Macula at the center of the field.
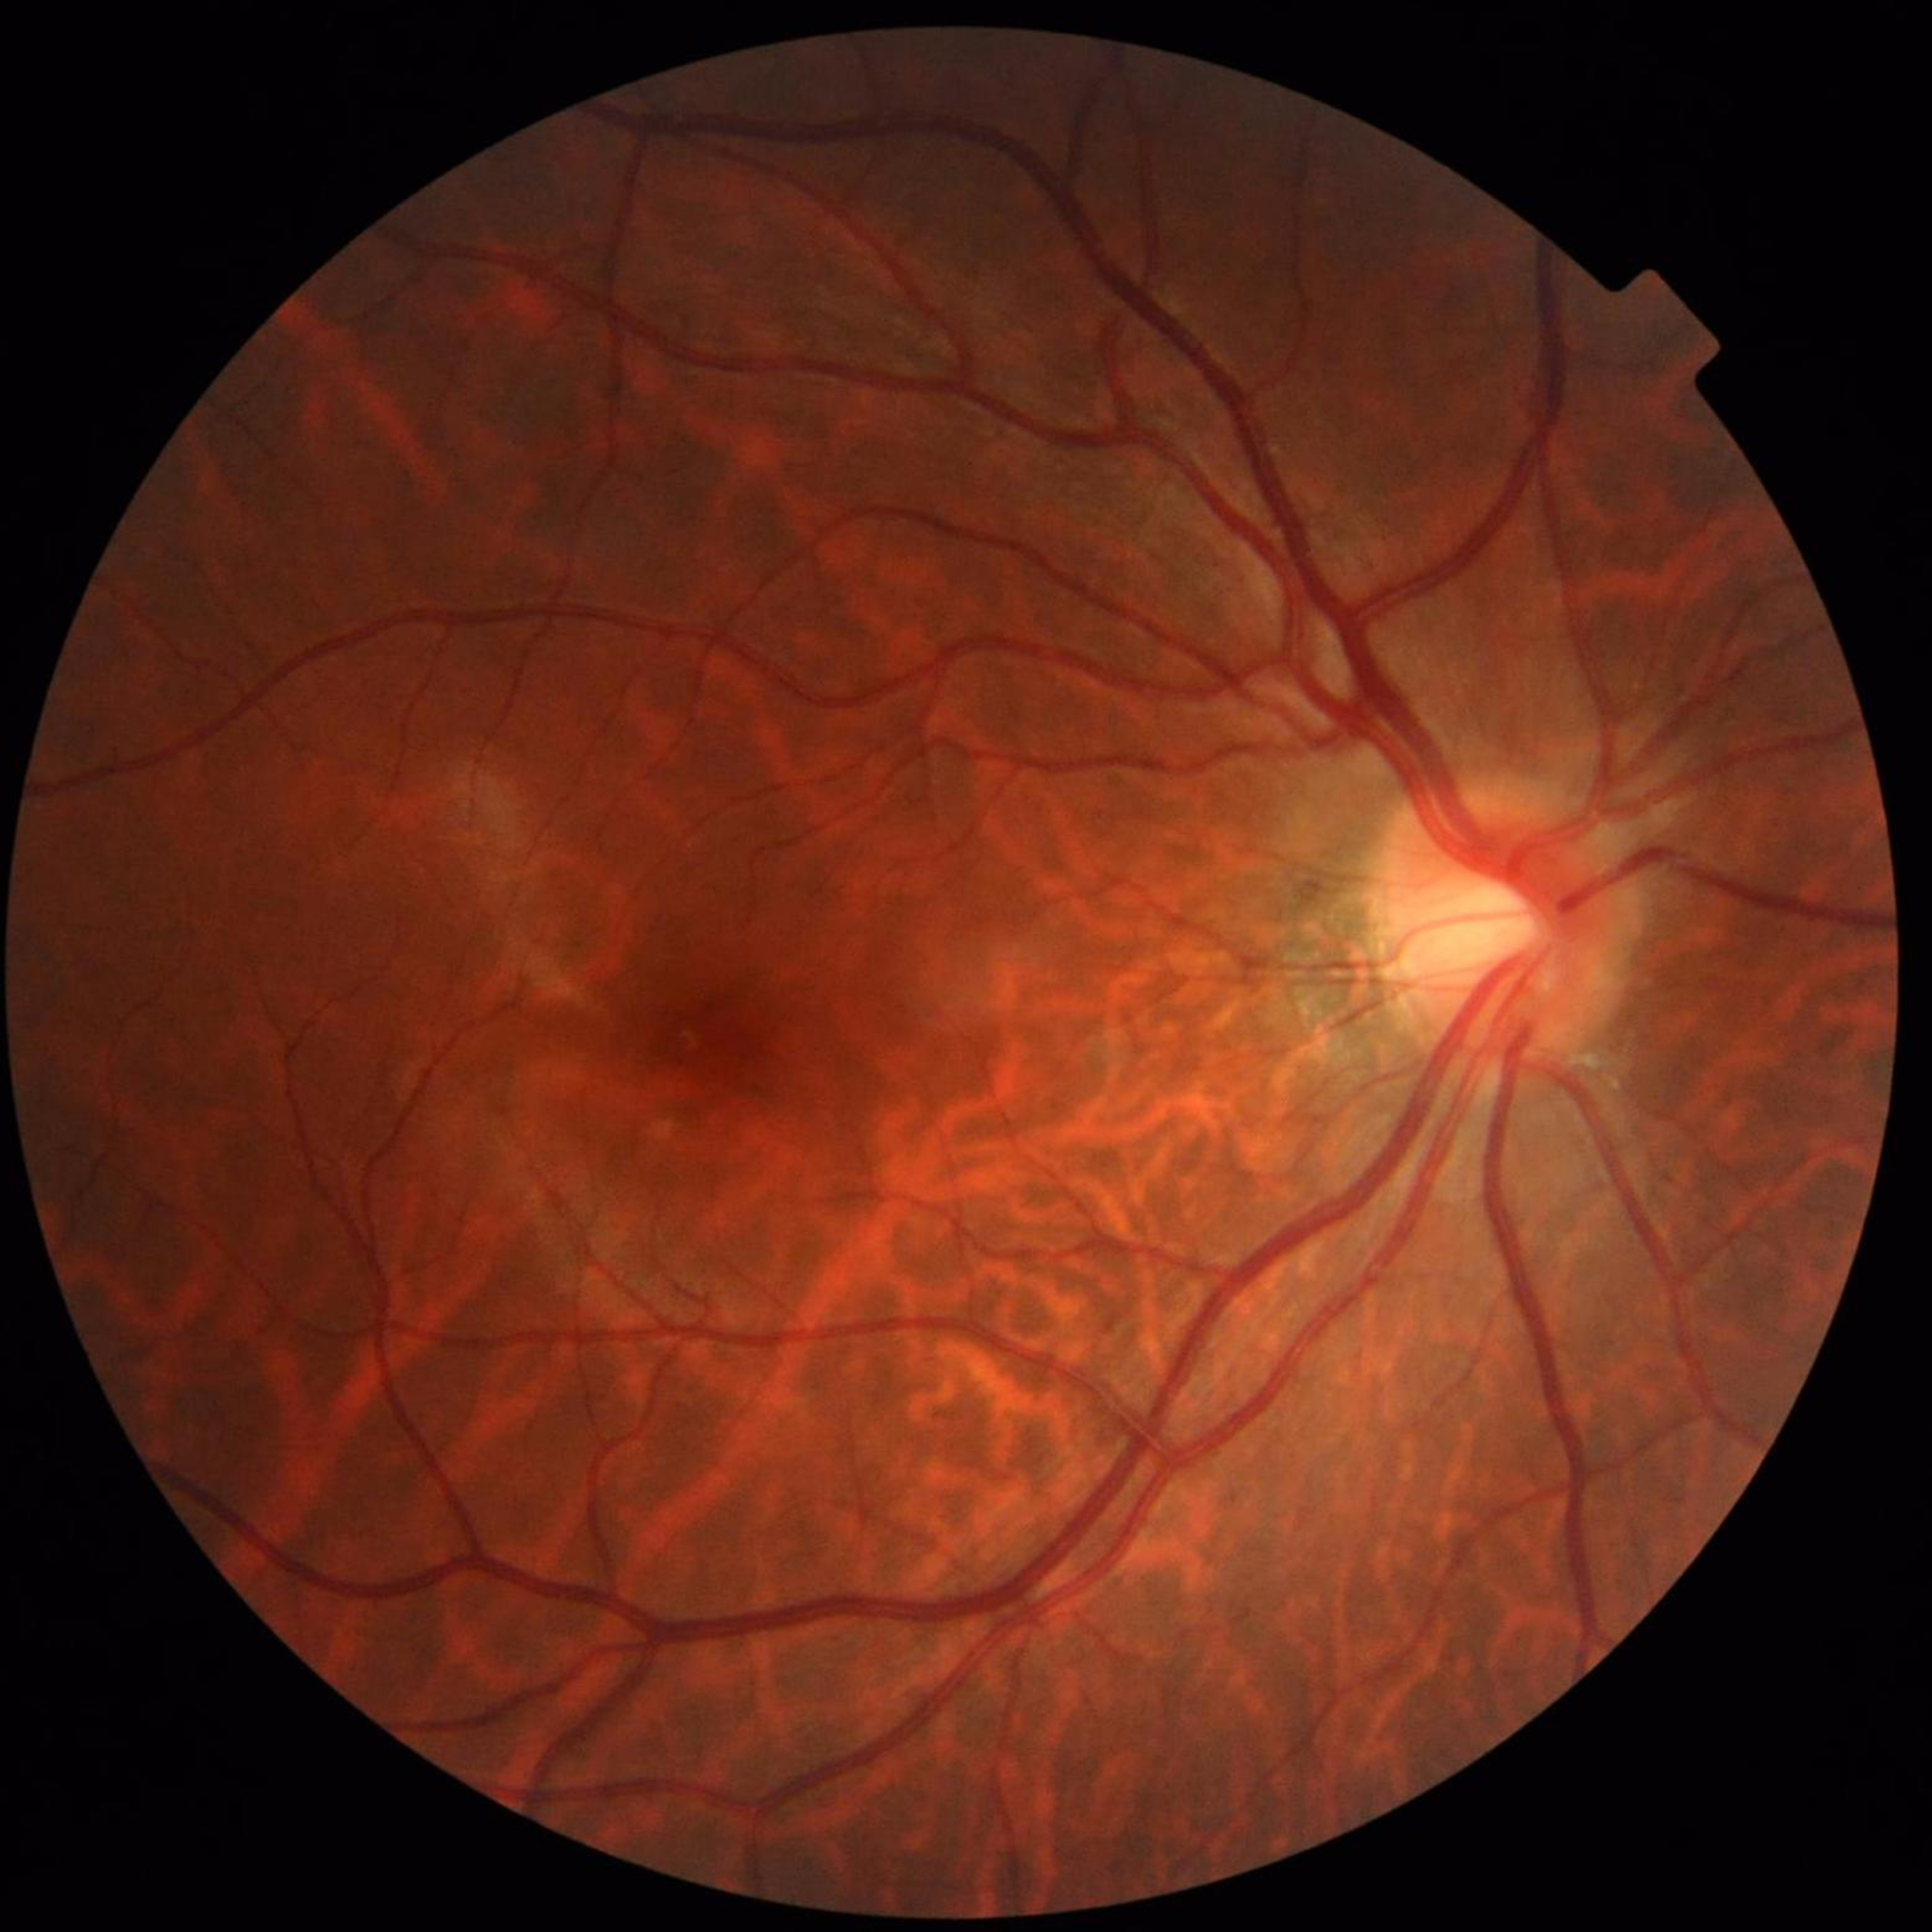
{"diagnosis": "no AMD, DR, or glaucomatous findings"}